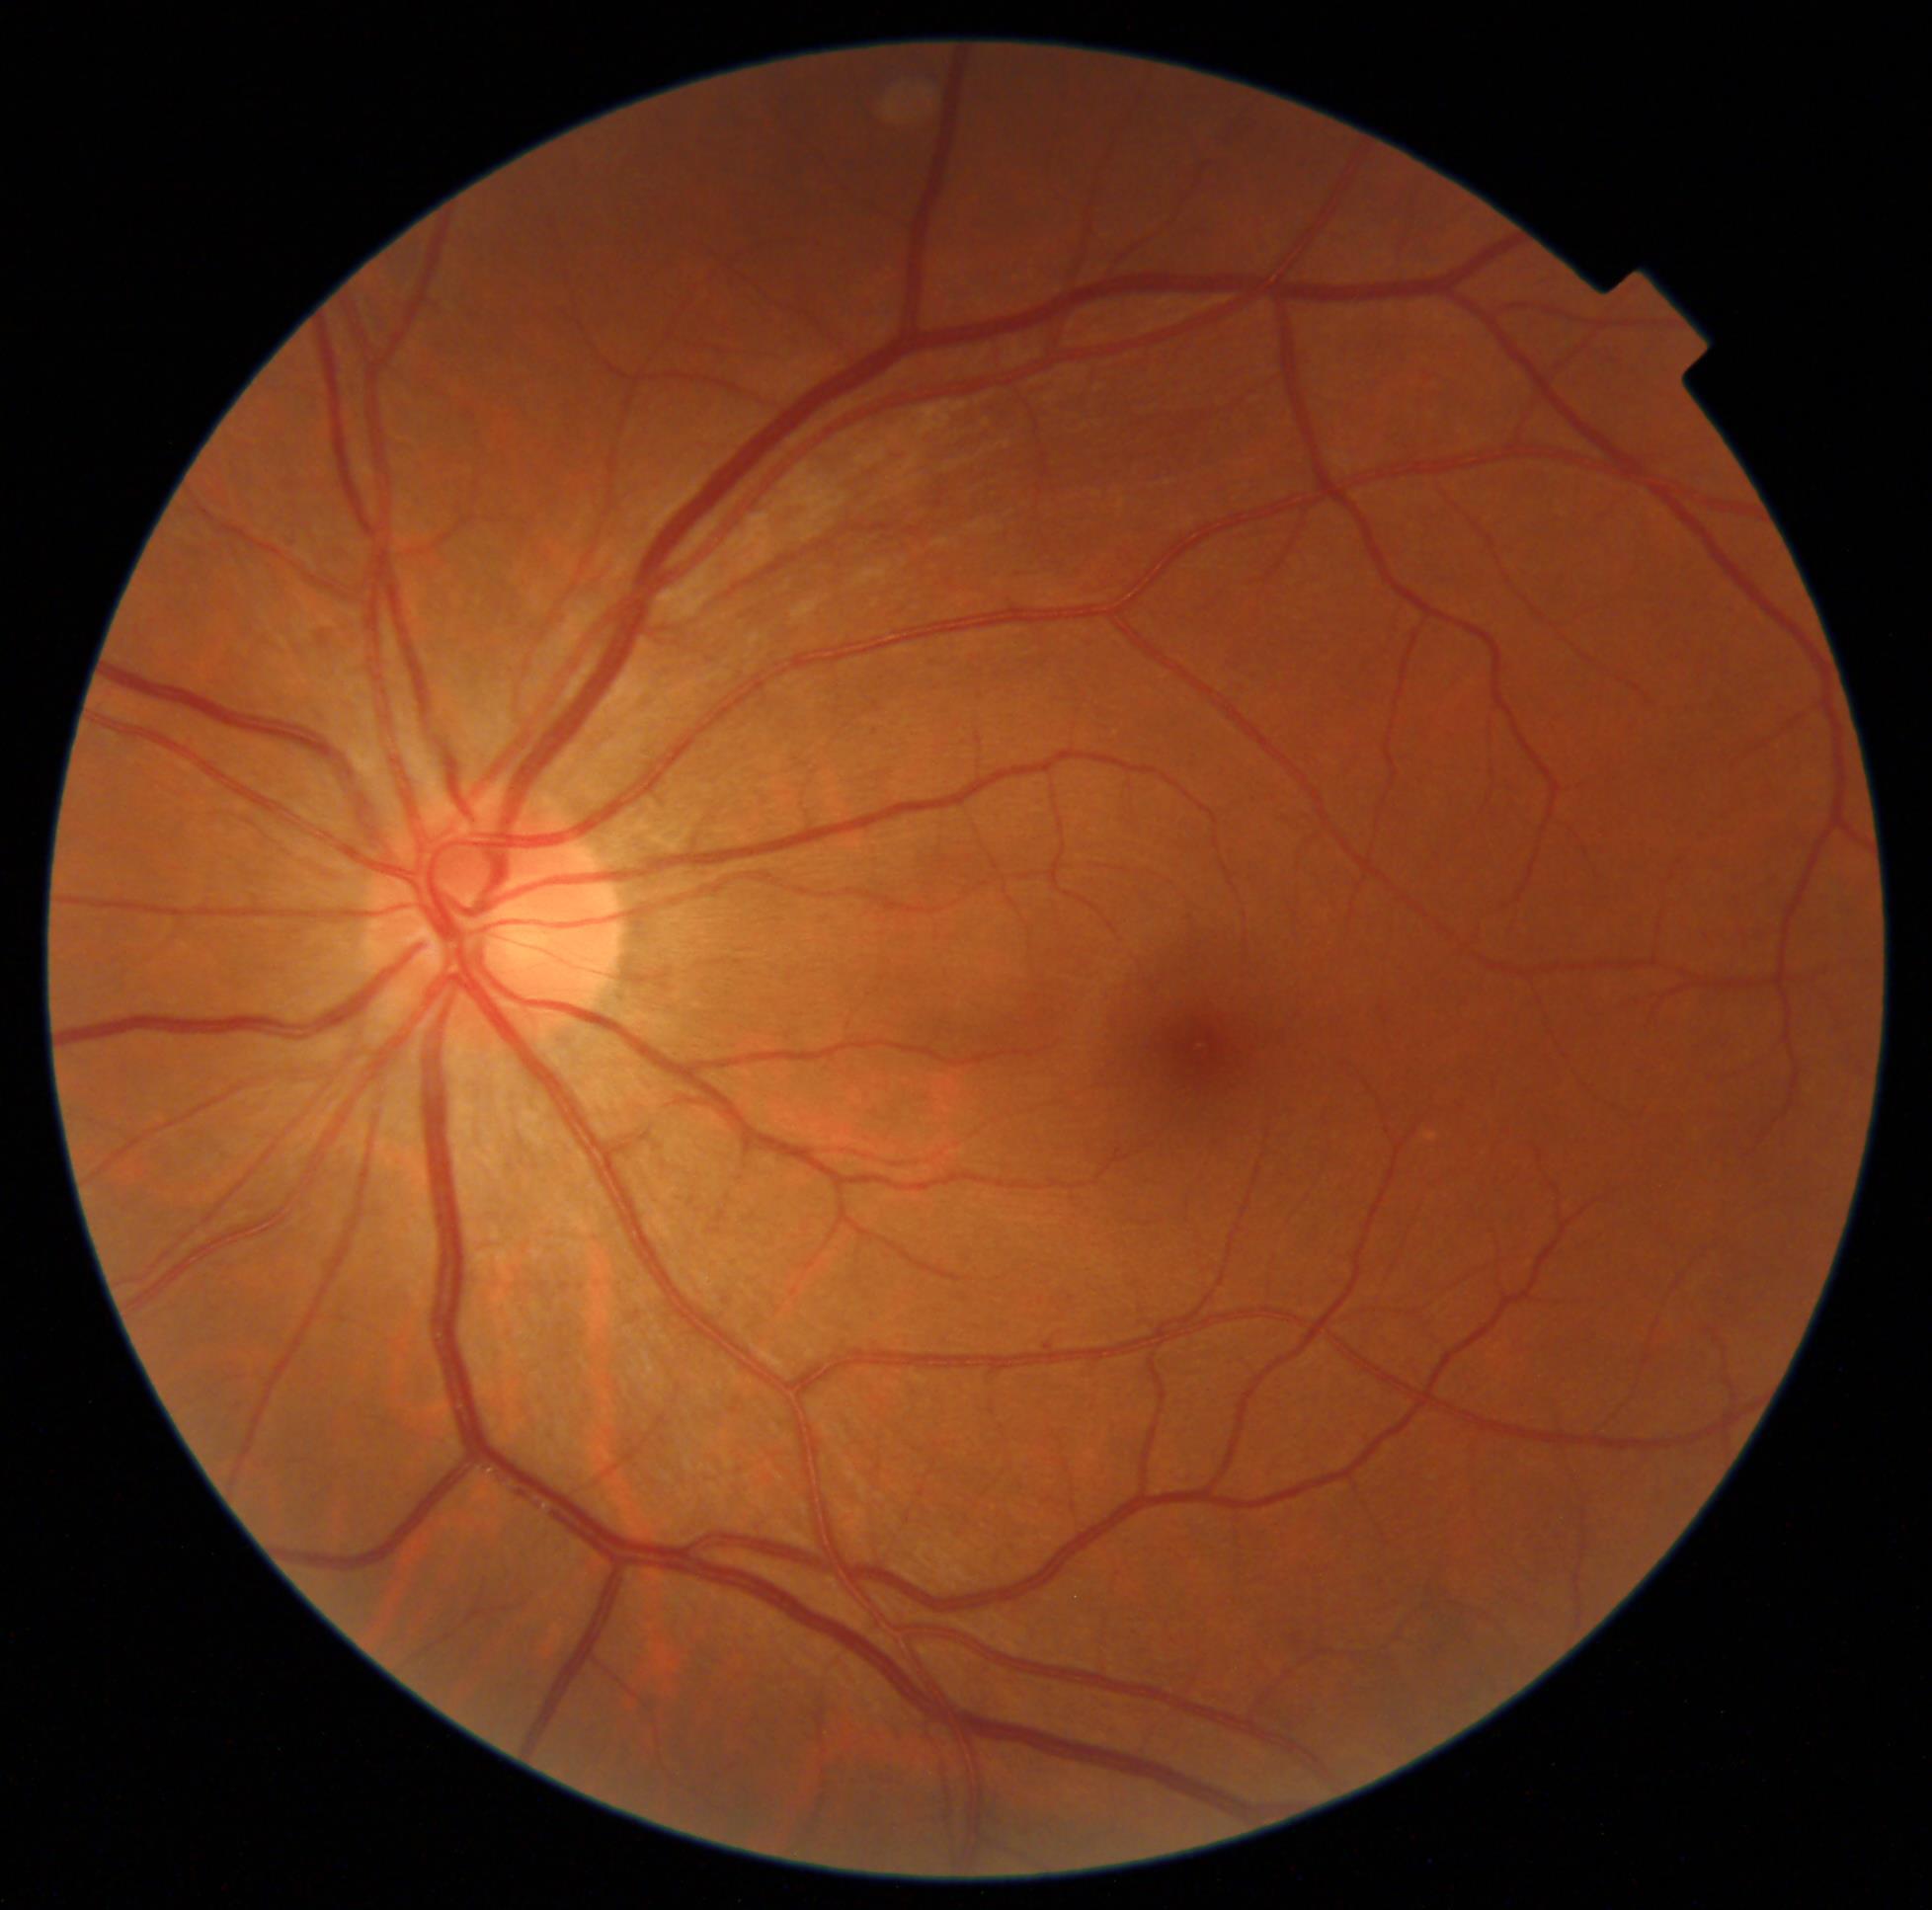

Annotations:
– DR class: non-proliferative diabetic retinopathy
– DR grade: 1